Infant wide-field fundus photograph.
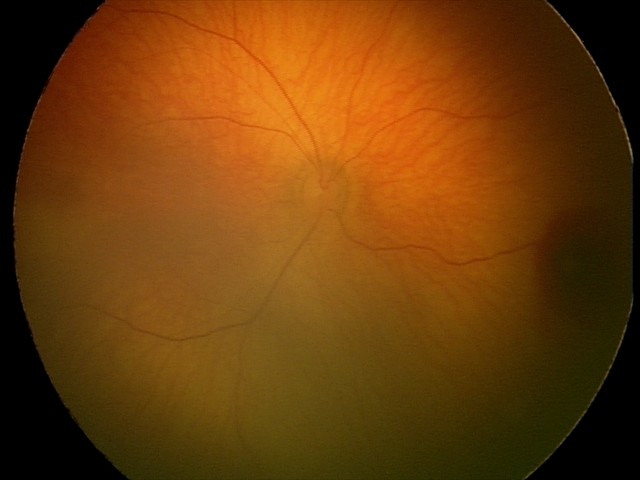 Examination diagnosed as retinal hemorrhages.